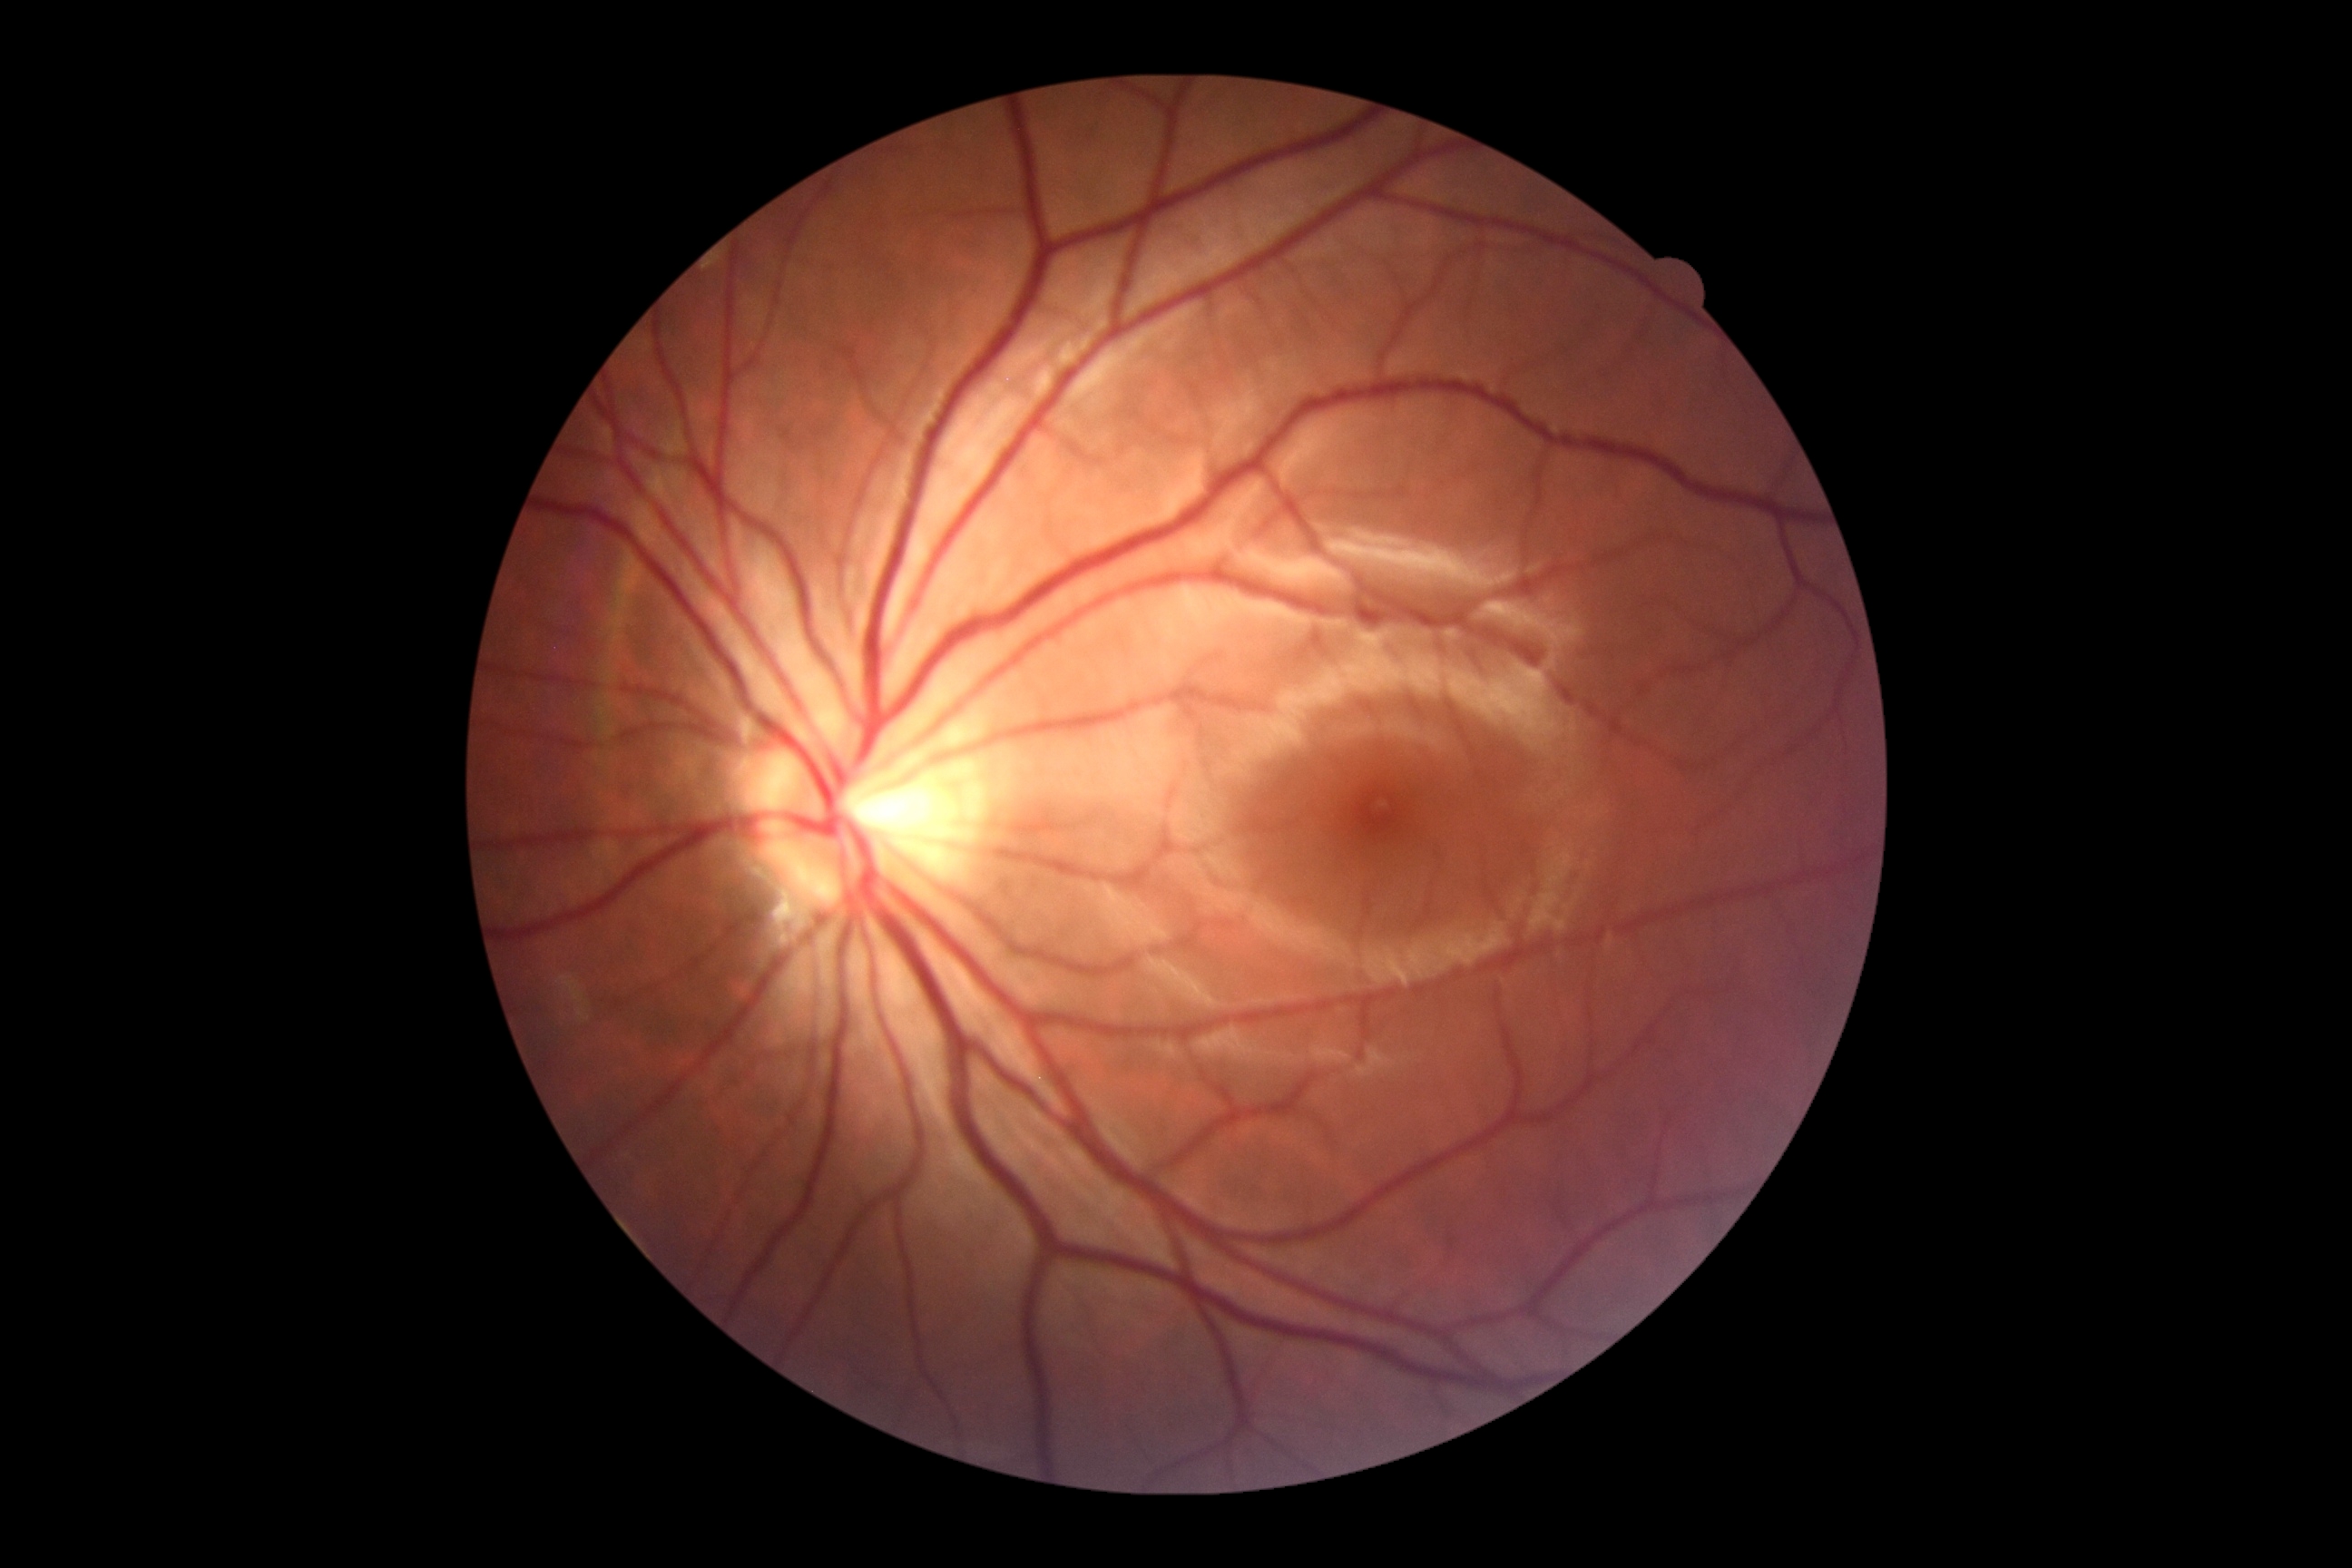

DR severity is 0. No signs of diabetic retinopathy.